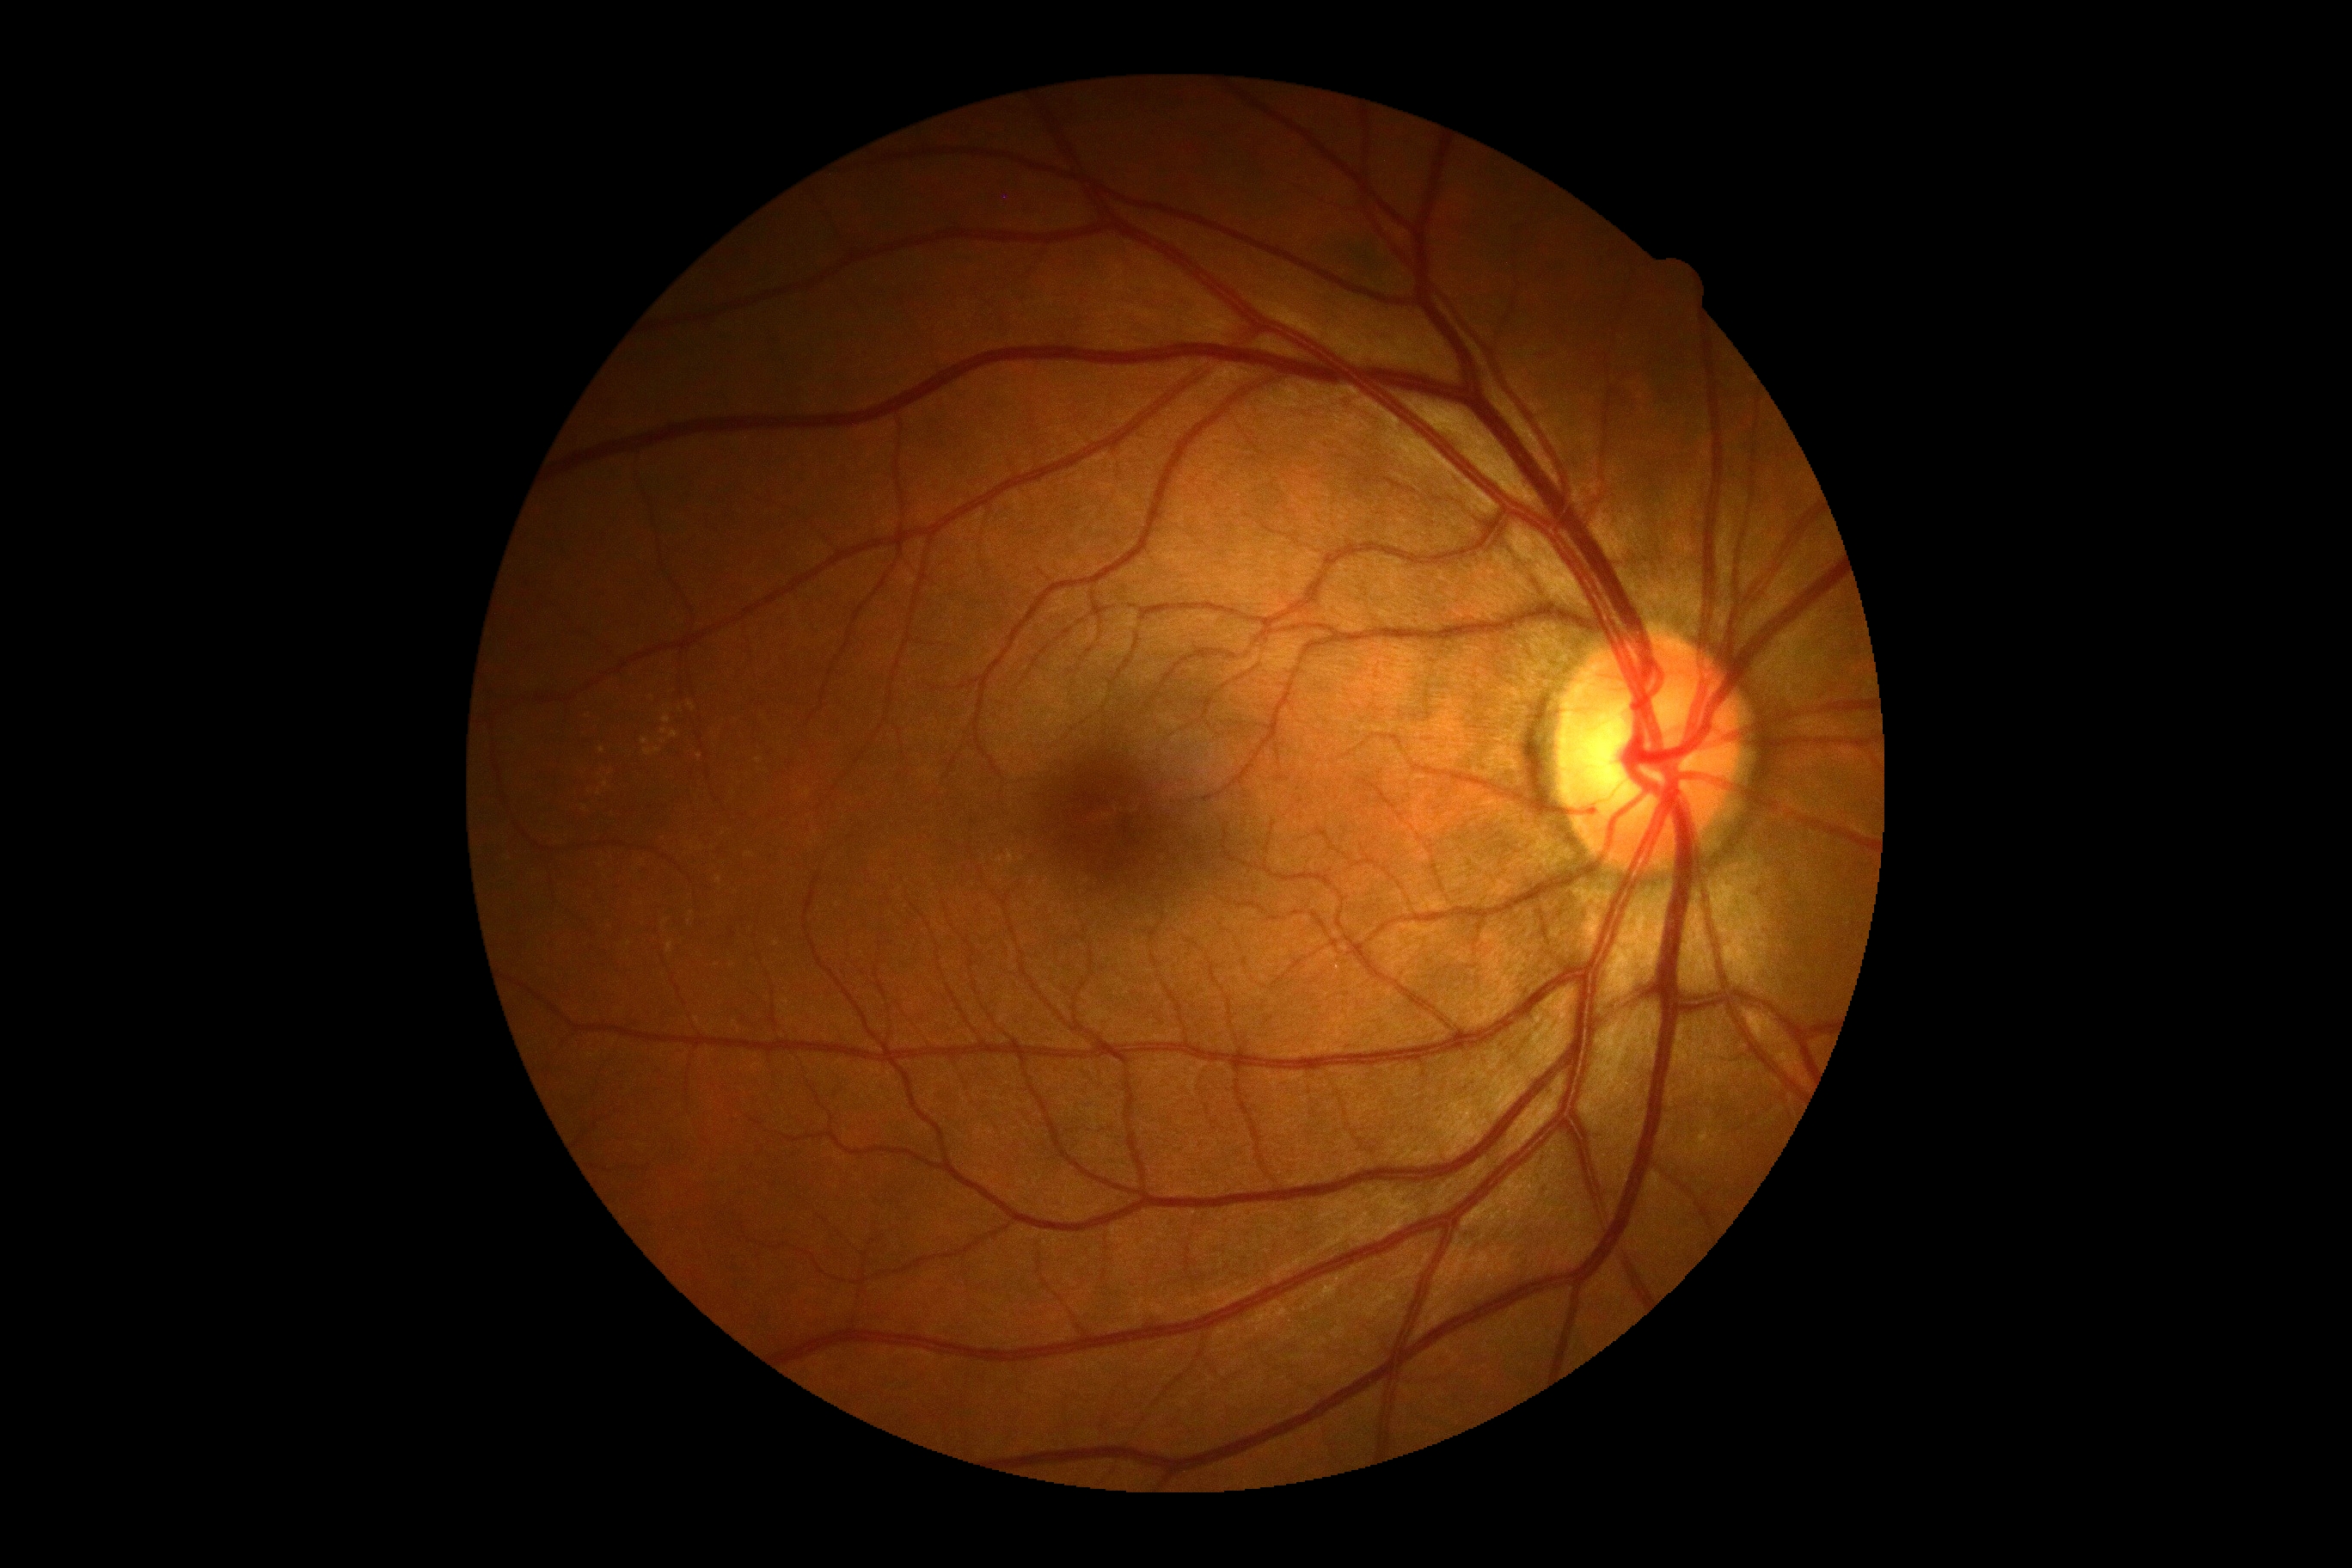
No diabetic retinal disease findings. Retinopathy: 0/4.